Nonmydriatic; modified Davis classification; 45° FOV: 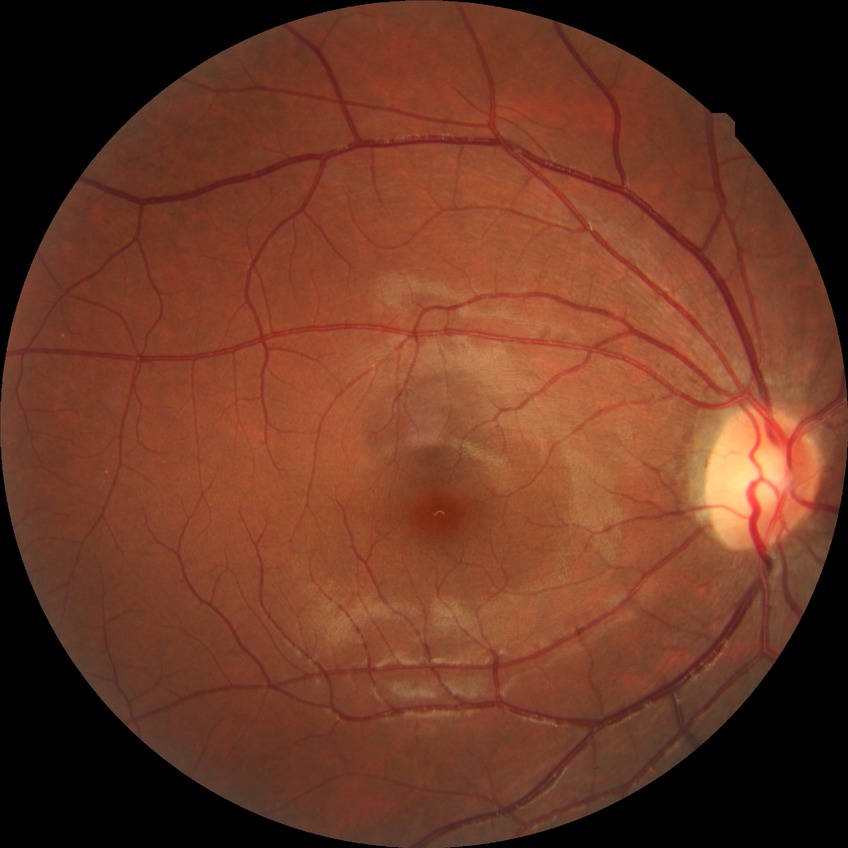

diabetic retinopathy (DR)@no diabetic retinopathy (NDR).